Acquired with a NIDEK AFC-230; 848x848; 45-degree field of view: 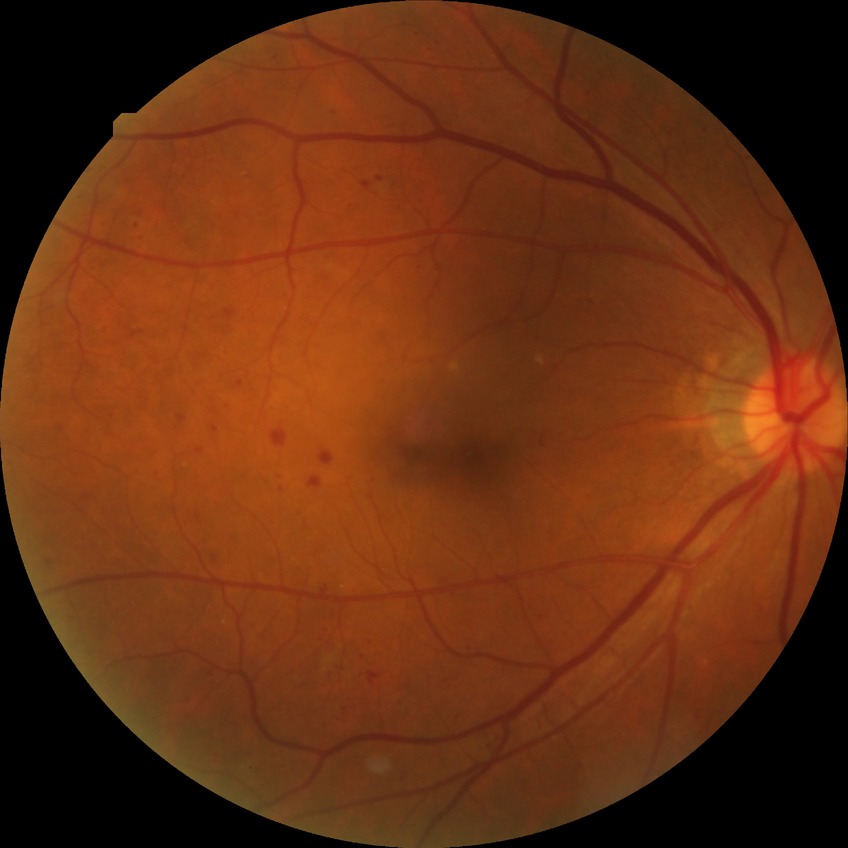

Diabetic retinopathy (DR) is simple diabetic retinopathy (SDR).